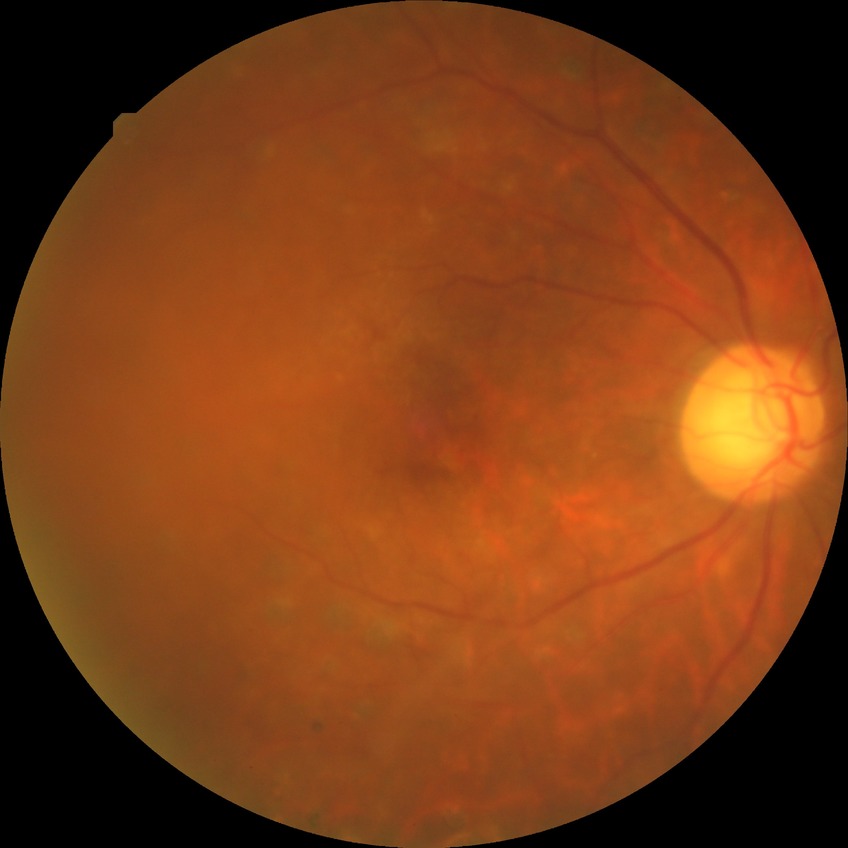

Diabetic retinopathy (DR): proliferative diabetic retinopathy (PDR).